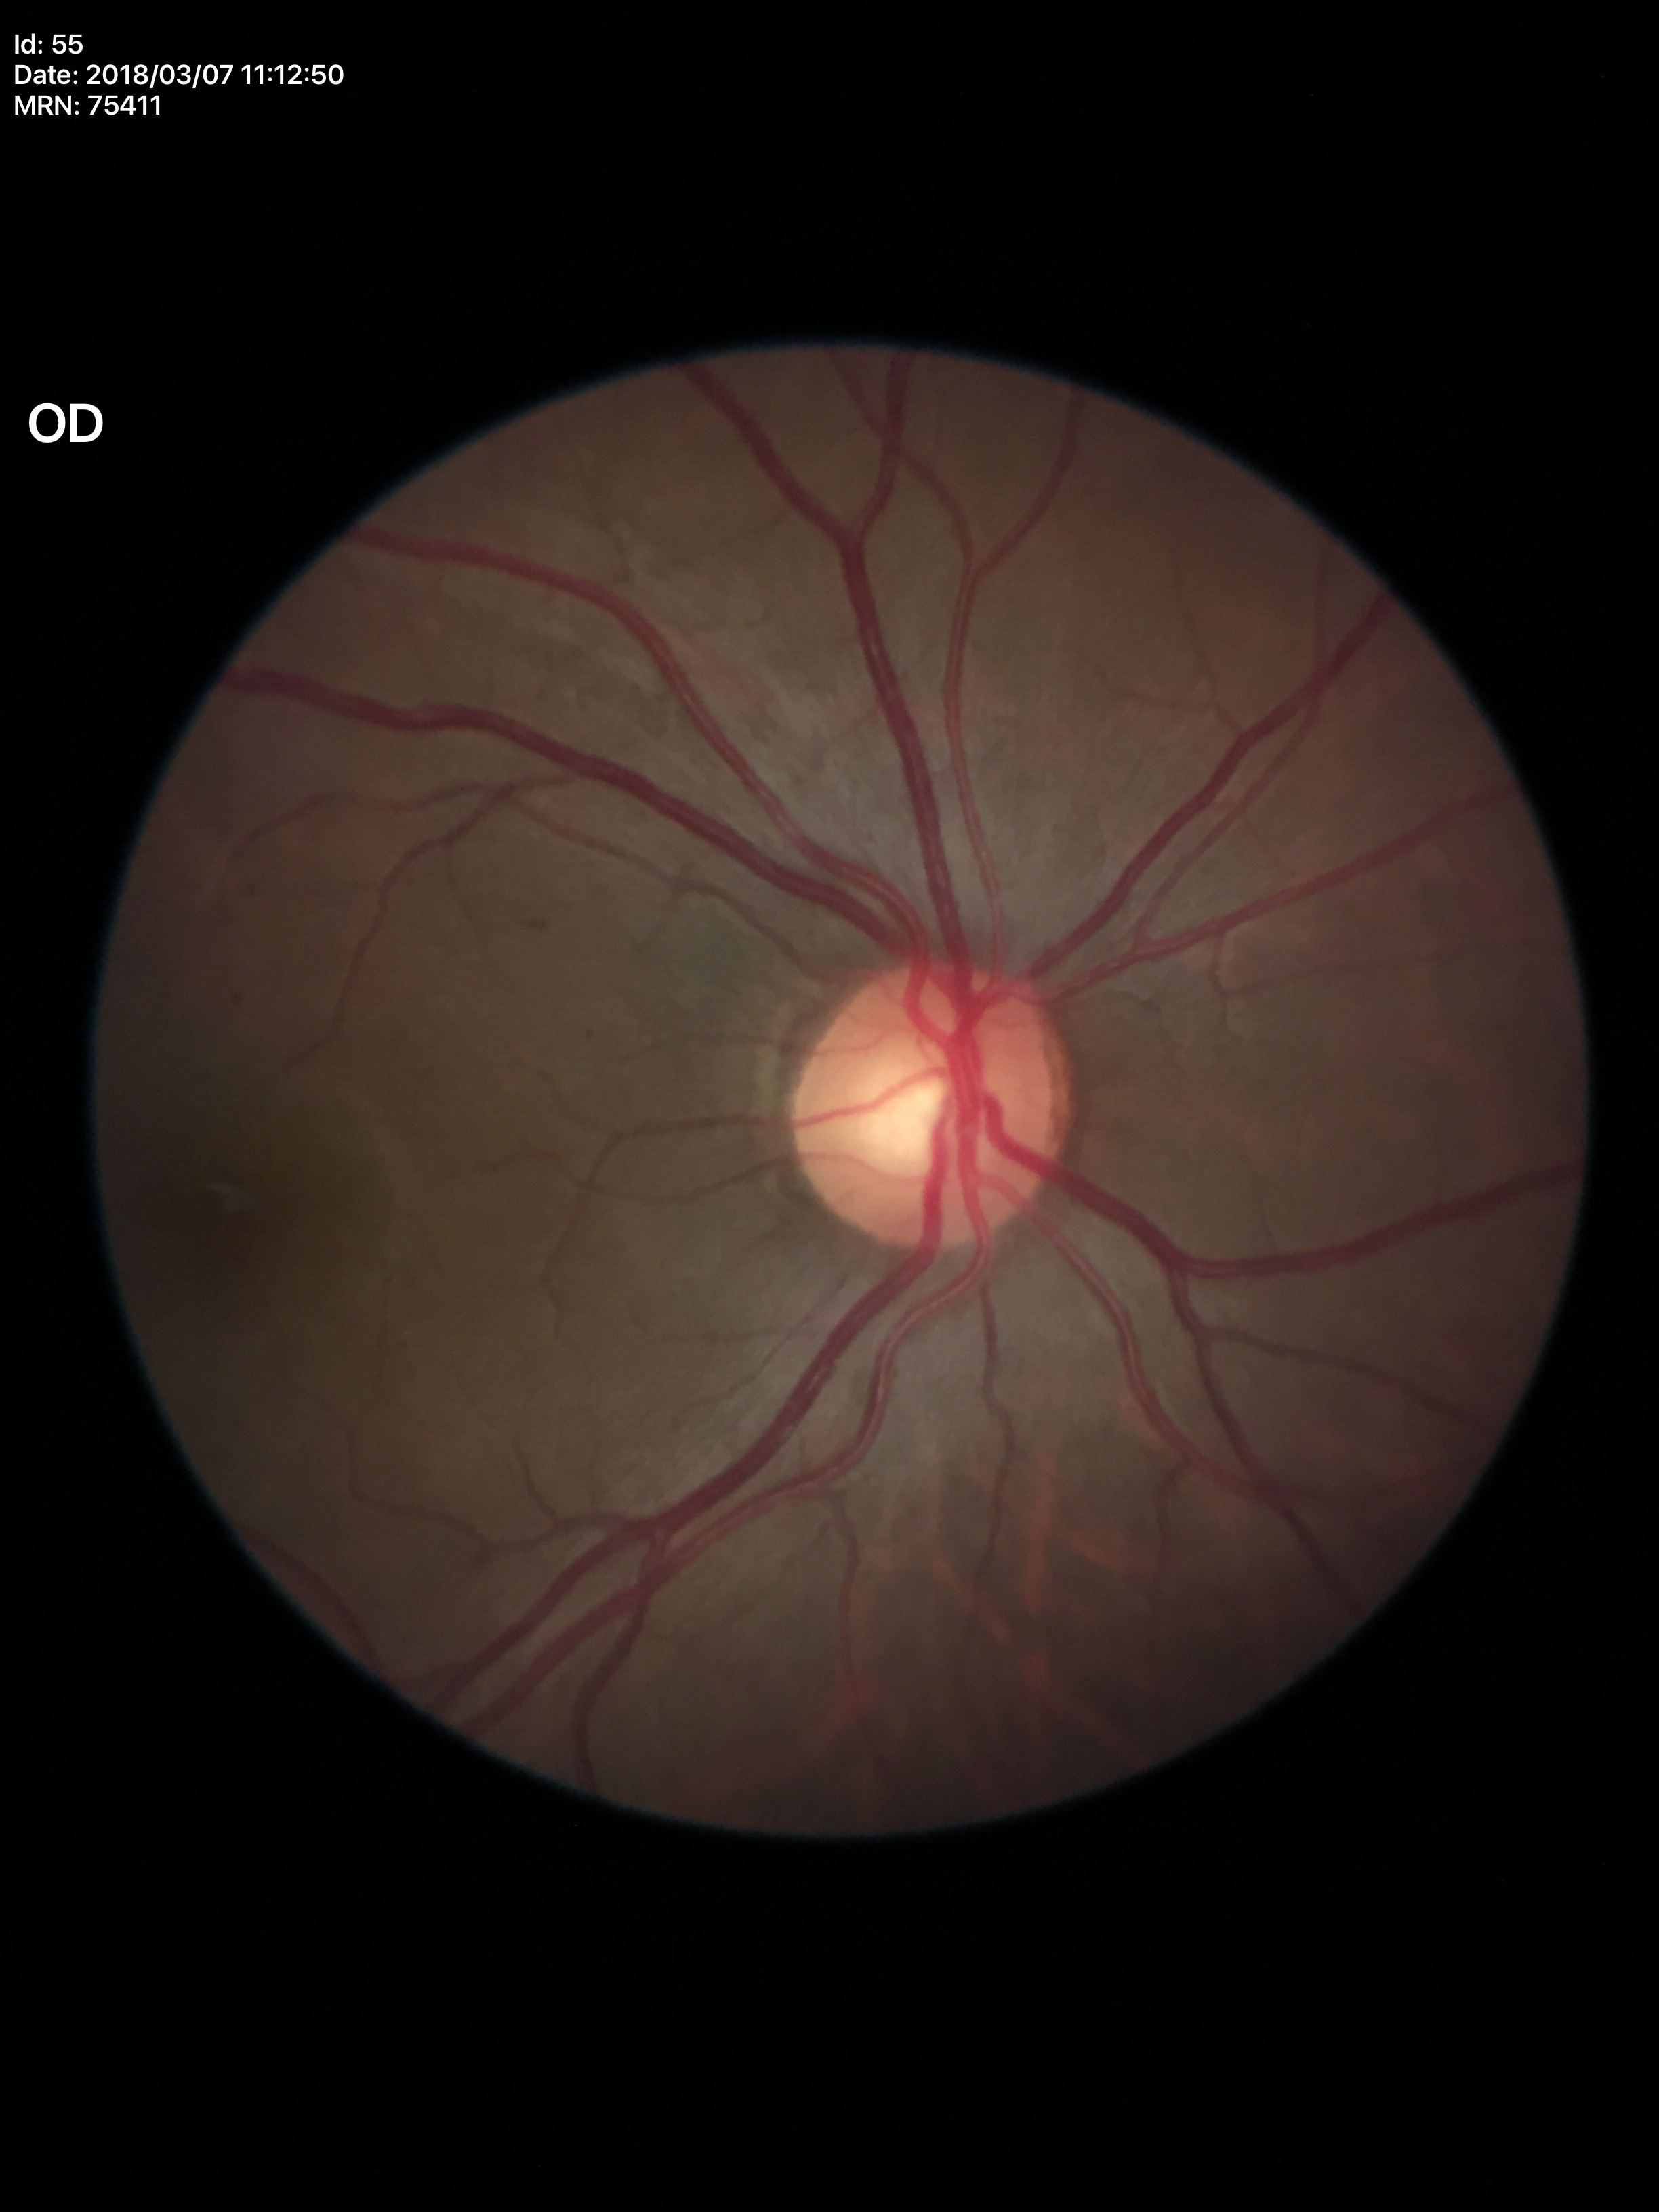
vertical cup-disc ratio (VCDR): 0.56
horizontal cup-disc ratio (HCDR): 0.58
Glaucoma assessment: negative (1 of 5 graders flagged glaucoma suspect)